1659x2212px, retinal fundus photograph.
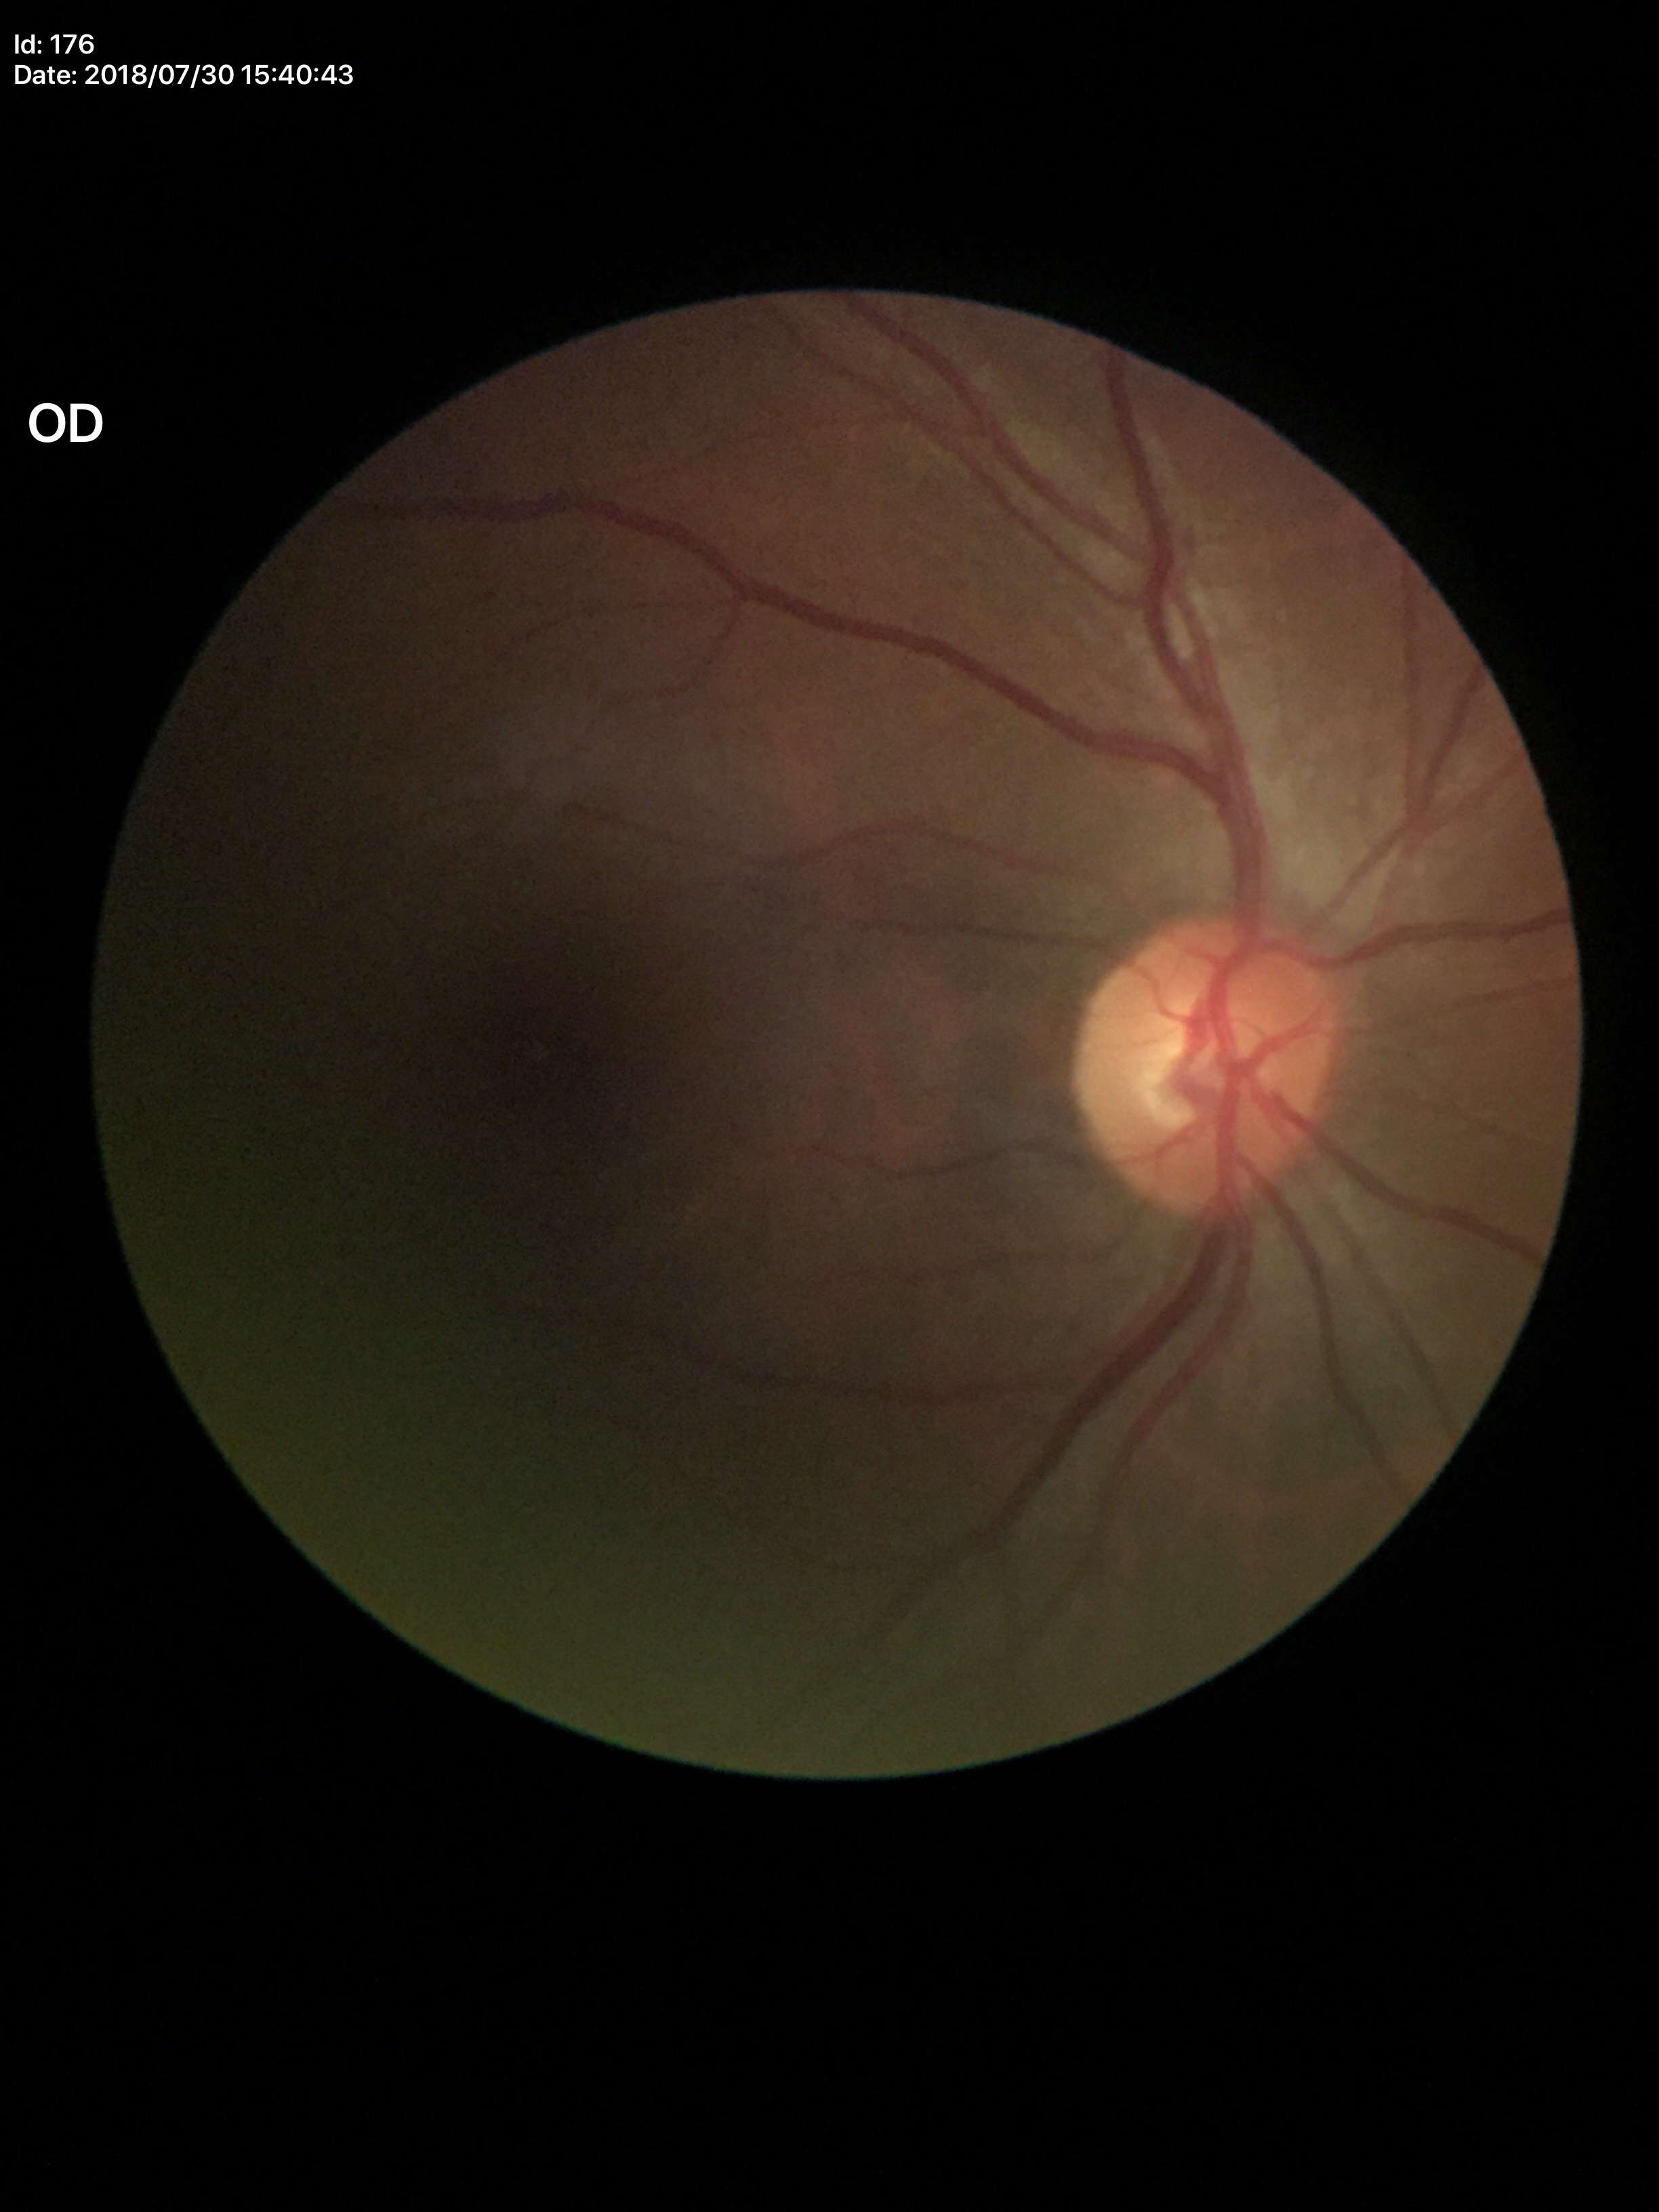 Glaucoma screening impression: negative.
Vertical CDR is 0.53.